Image size 848x848 — 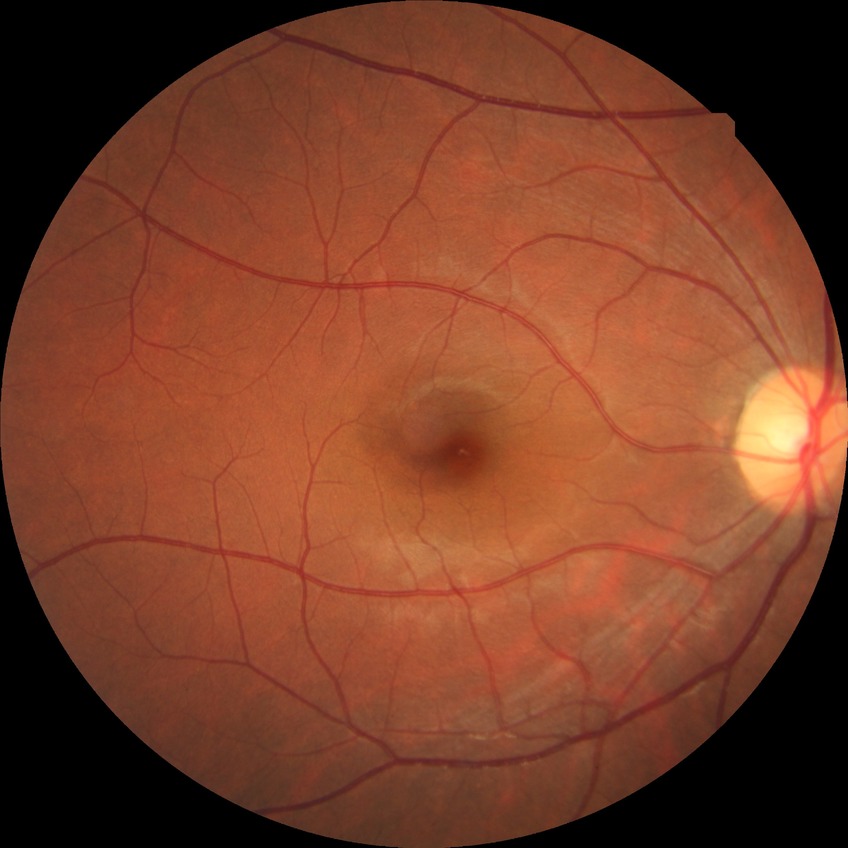

Retinopathy grade is no diabetic retinopathy.